Pediatric retinal photograph (wide-field): 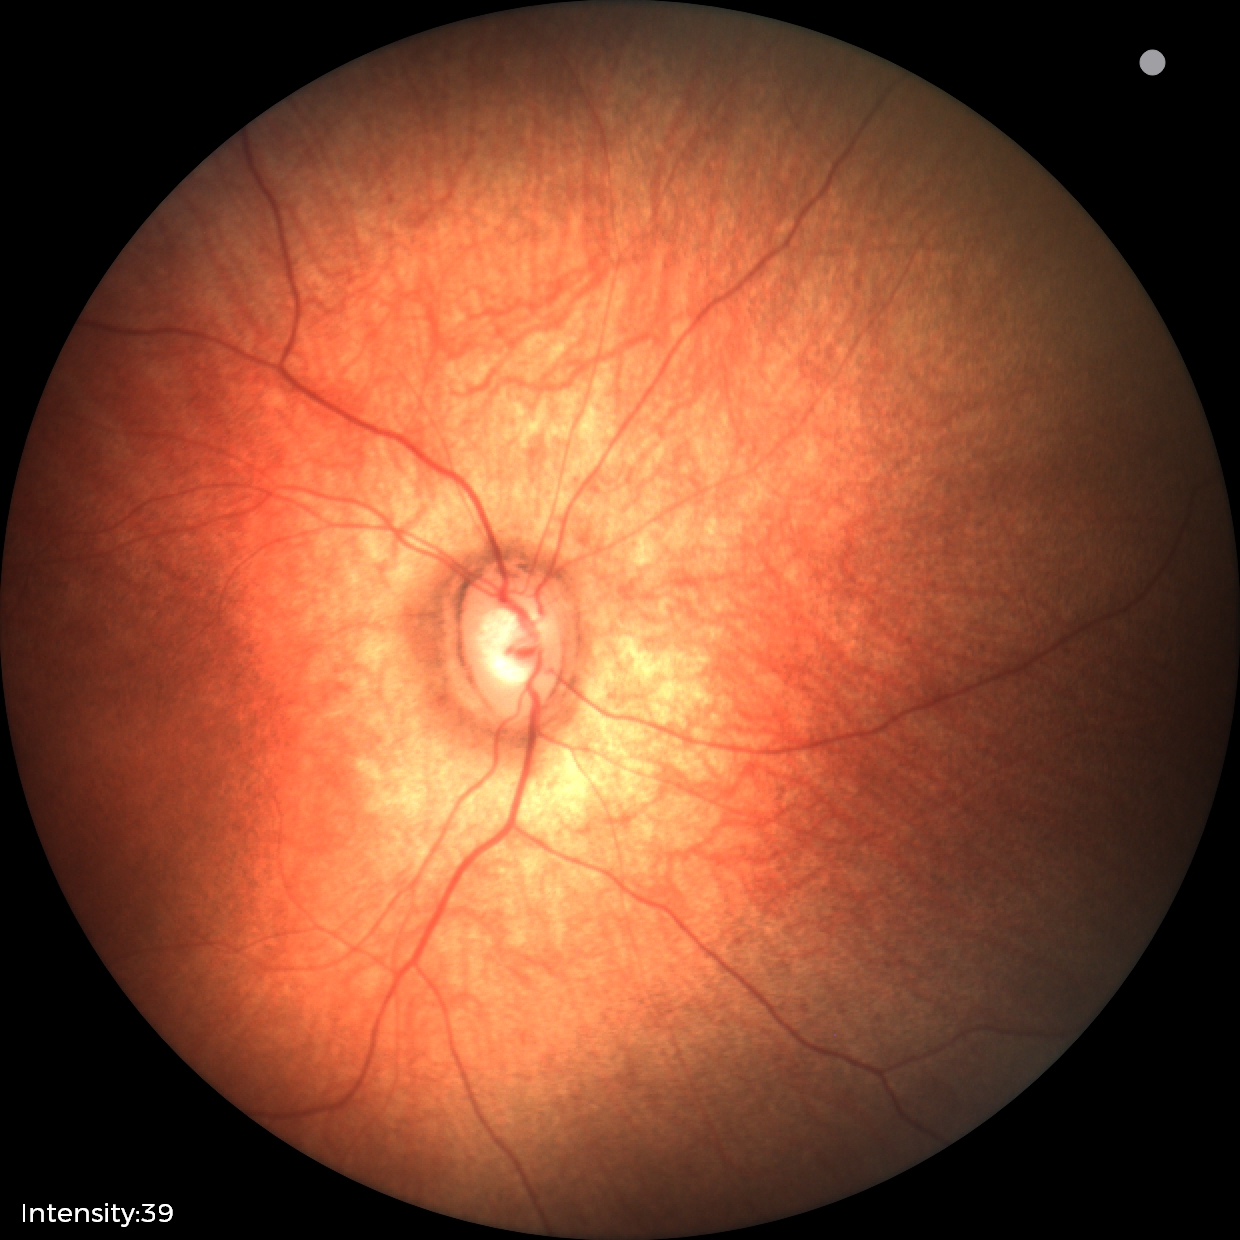
Screening diagnosis: physiological appearance.